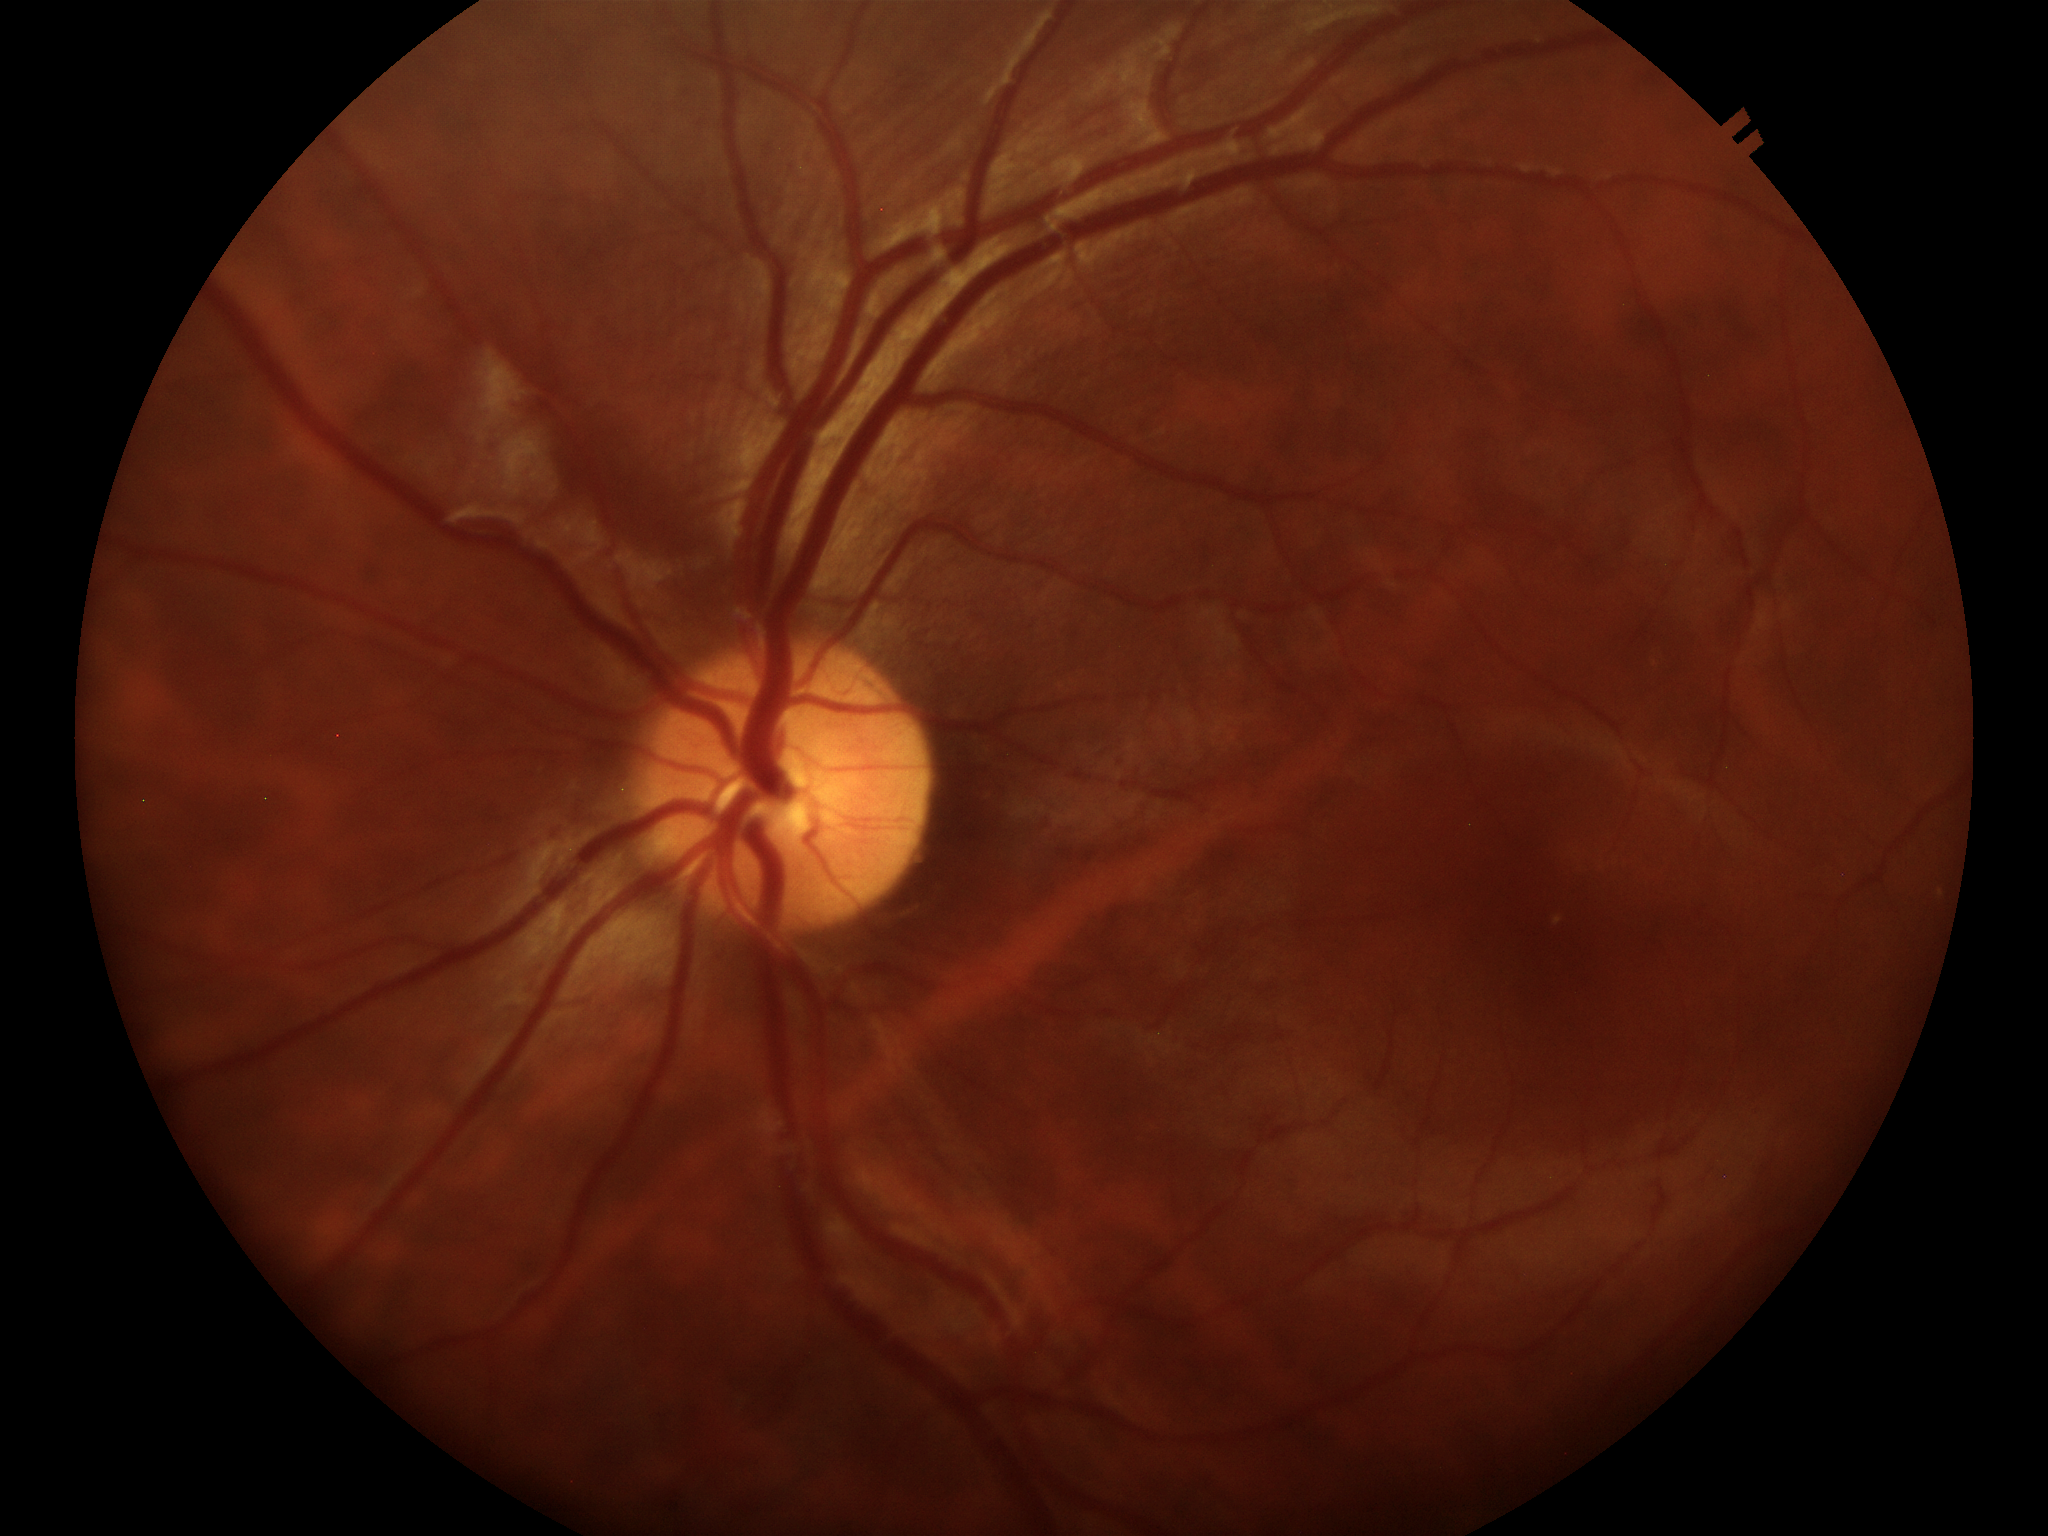

Glaucoma screening = no suspicious findings
vertical CDR = 0.47